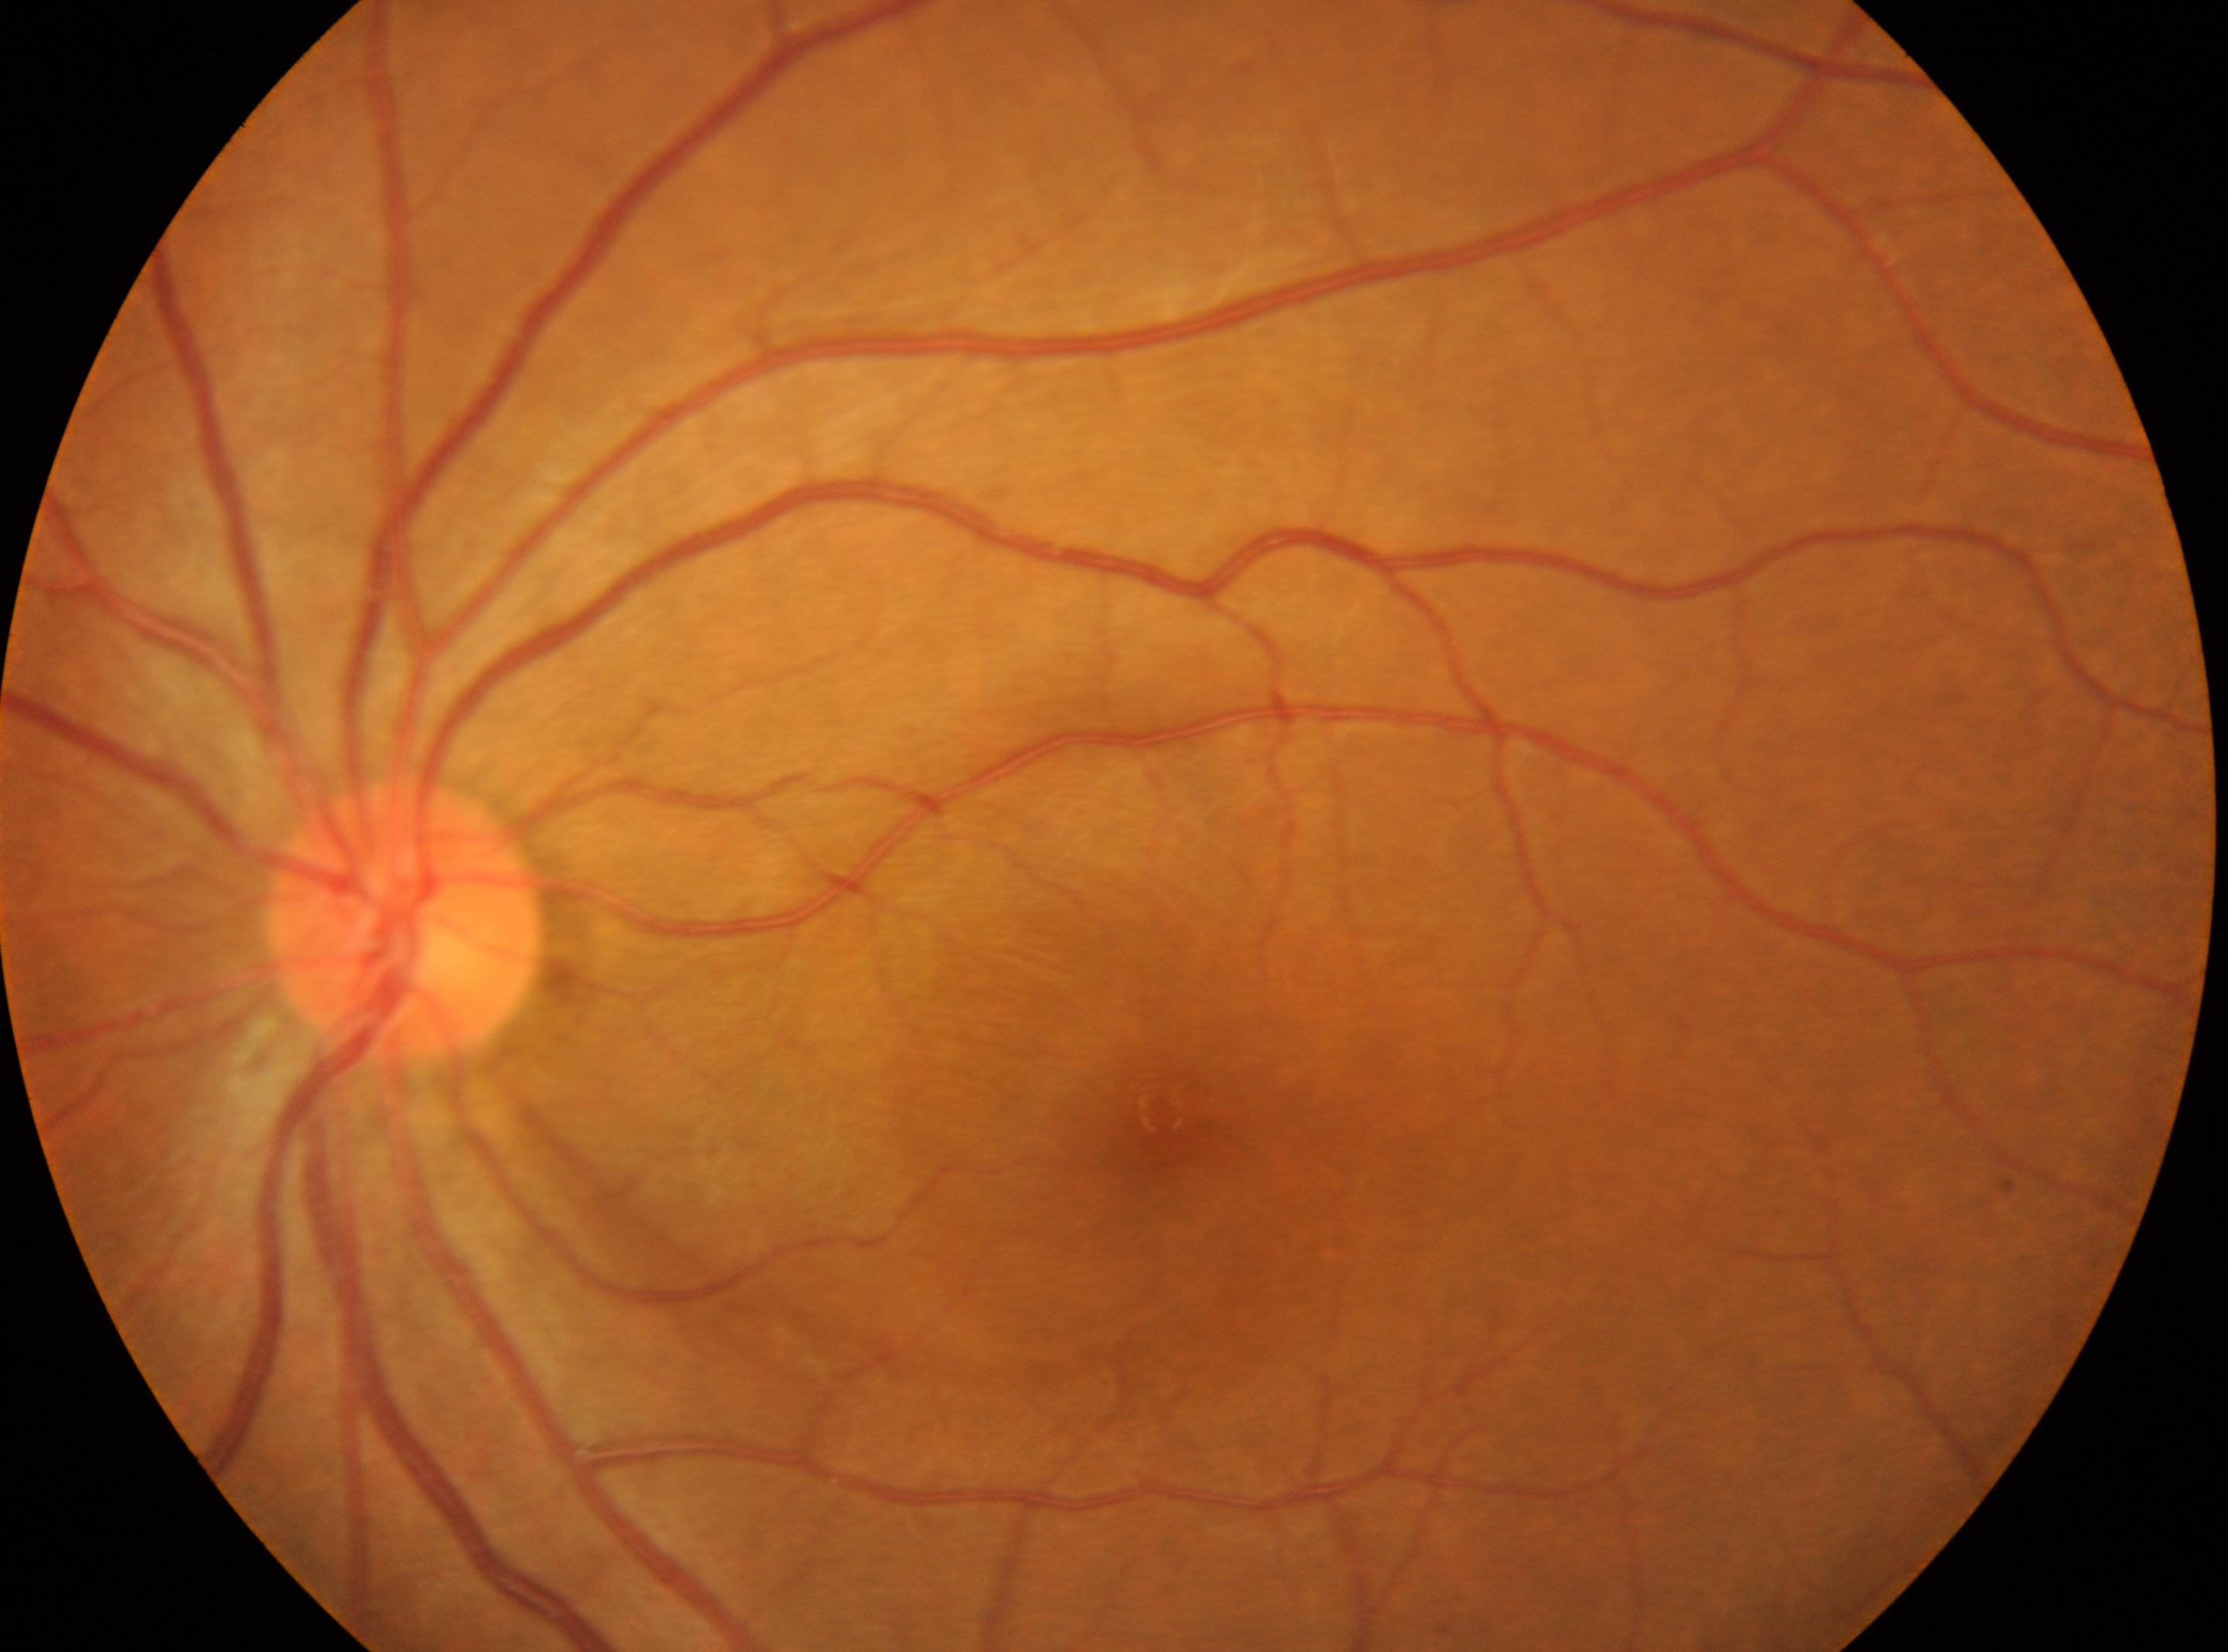

Q: Locate the fovea.
A: x=1159, y=1109
Q: Locate the optic disc.
A: x=407, y=919
Q: What is the DR grade?
A: 0/4
Q: What is the laterality?
A: OS